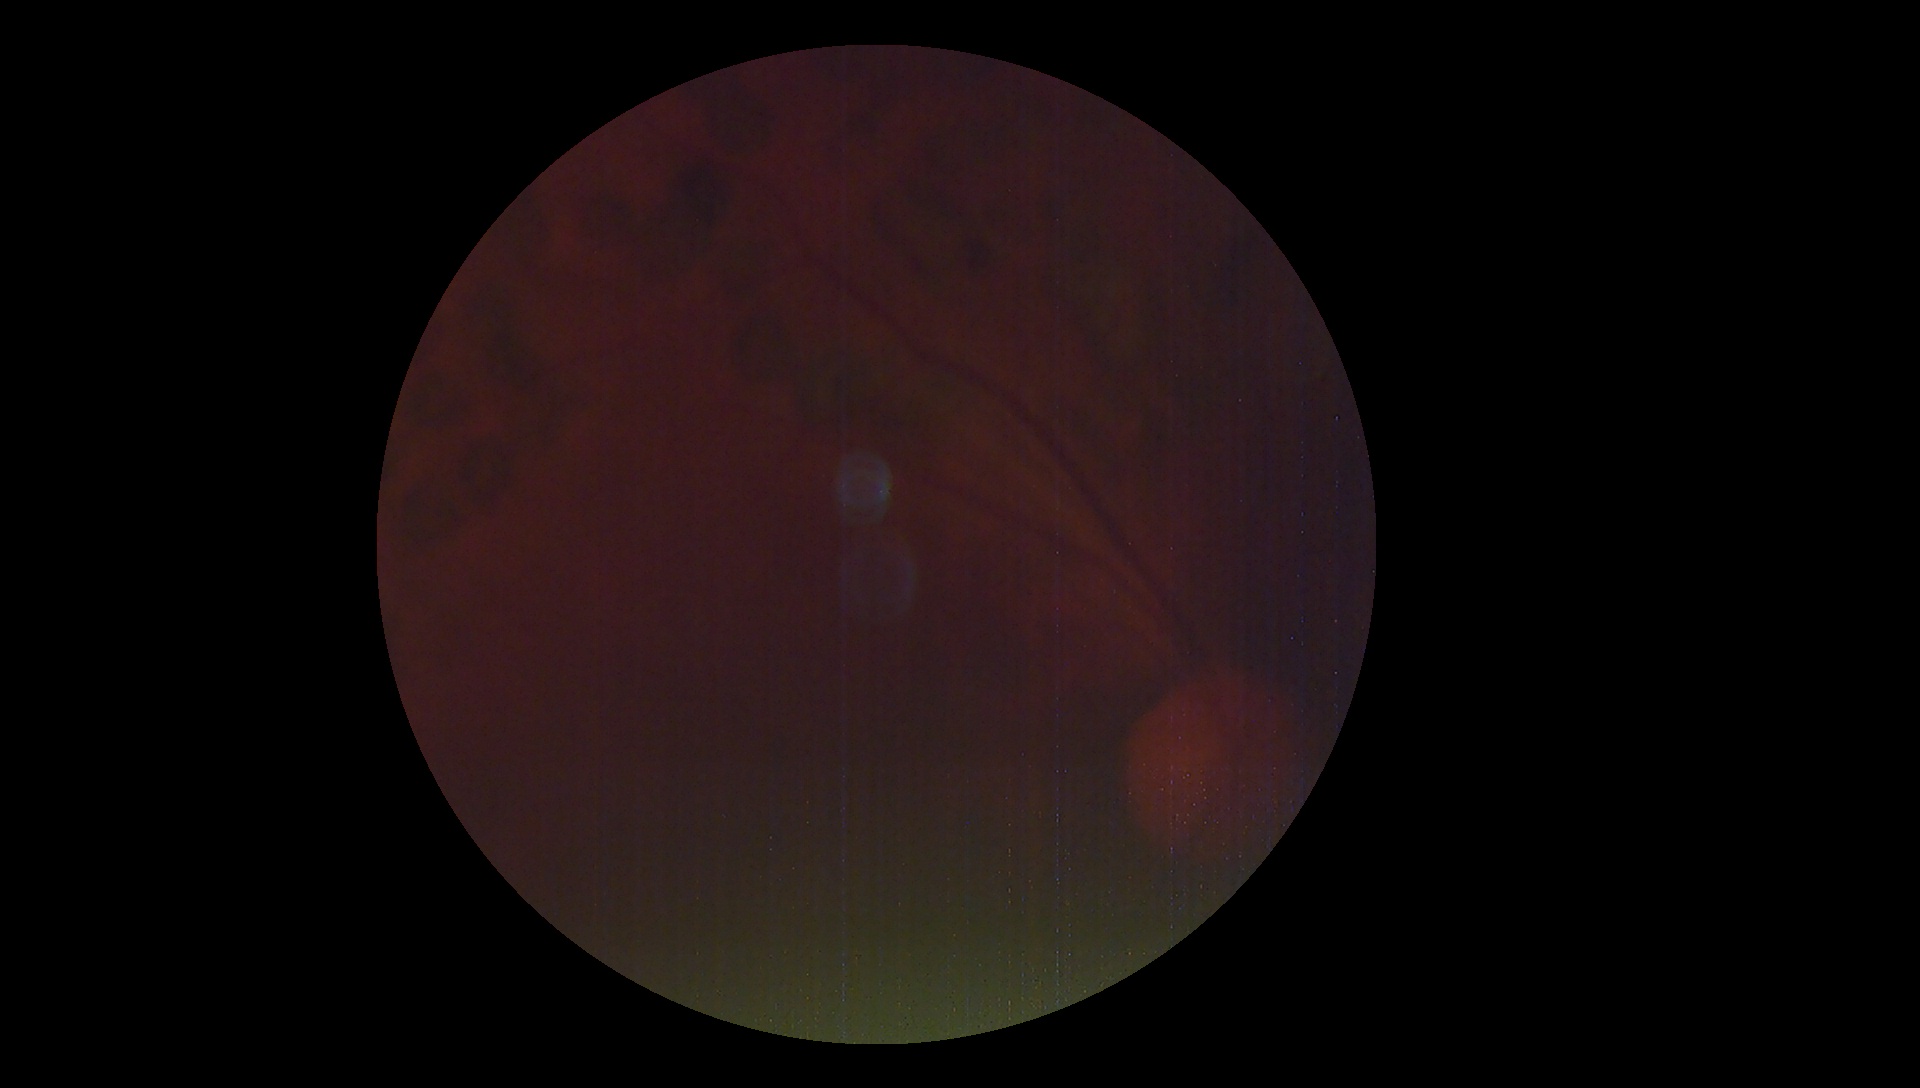 DR=ungradable due to poor image quality.